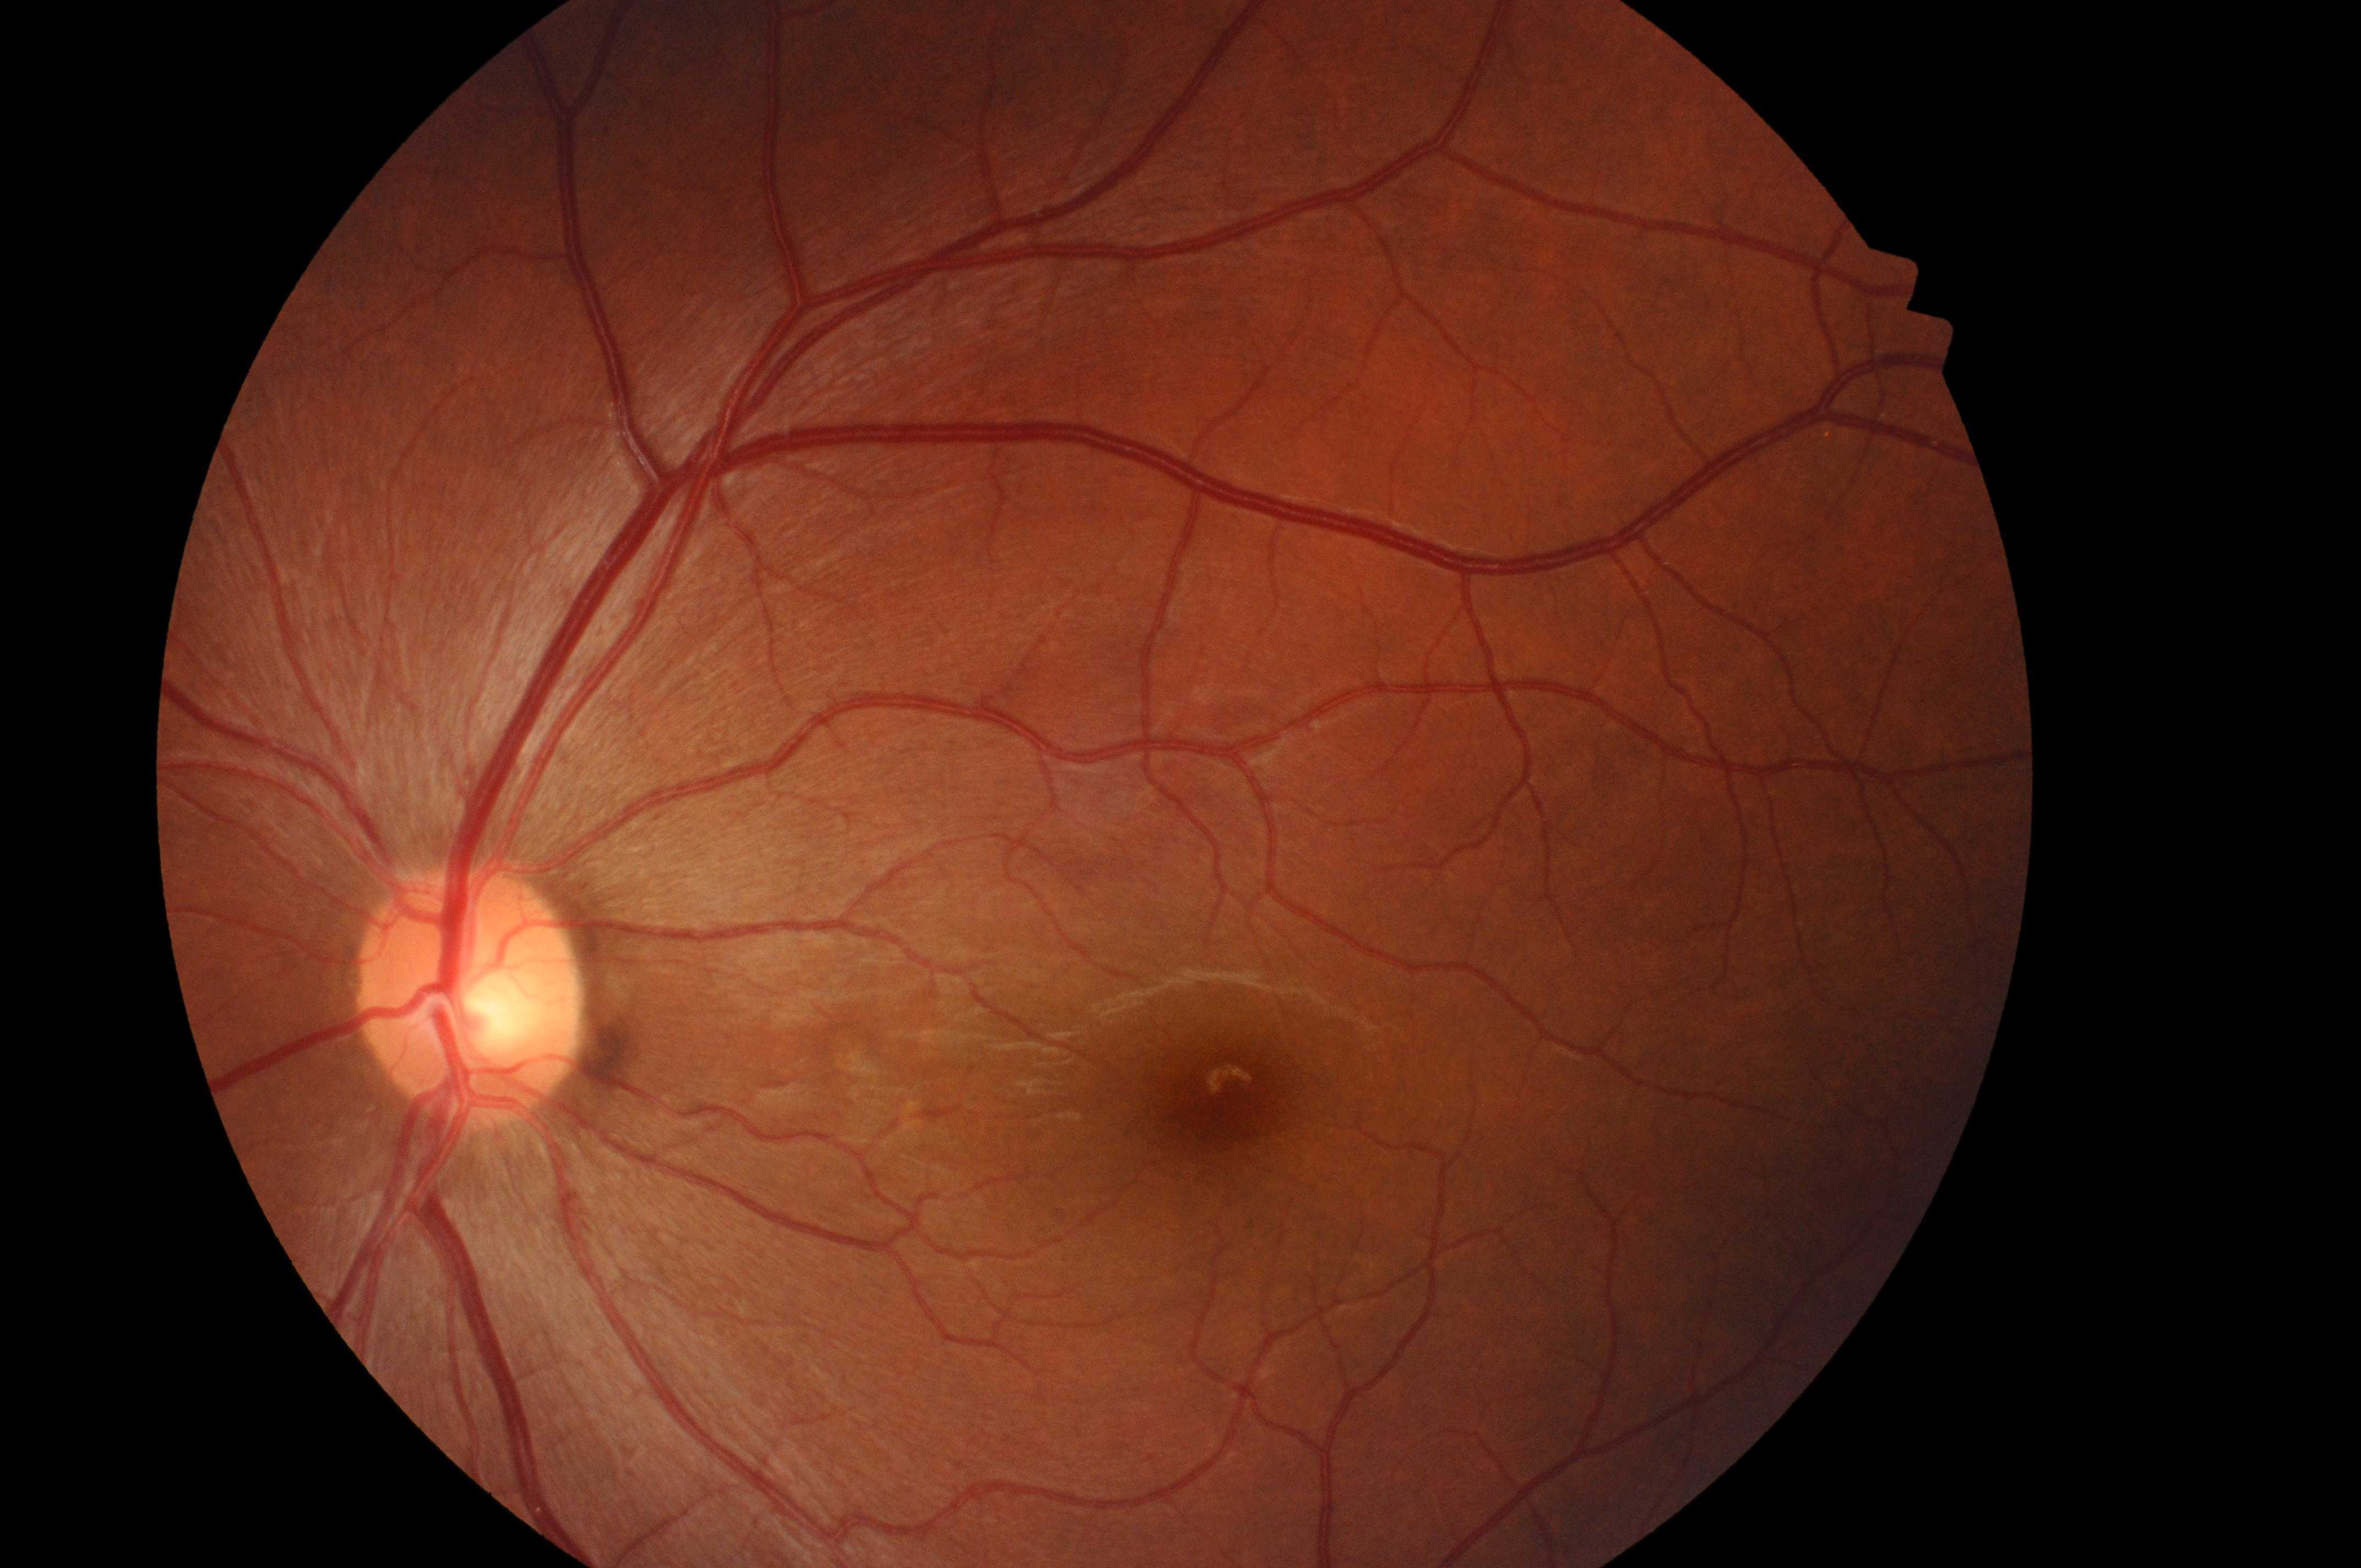 Eye: left eye.
DME grade: 0.
Optic disk: 466, 1004.
Fovea centralis located at 1238, 1107.
No diabetic retinal disease findings.
DR: grade 0.